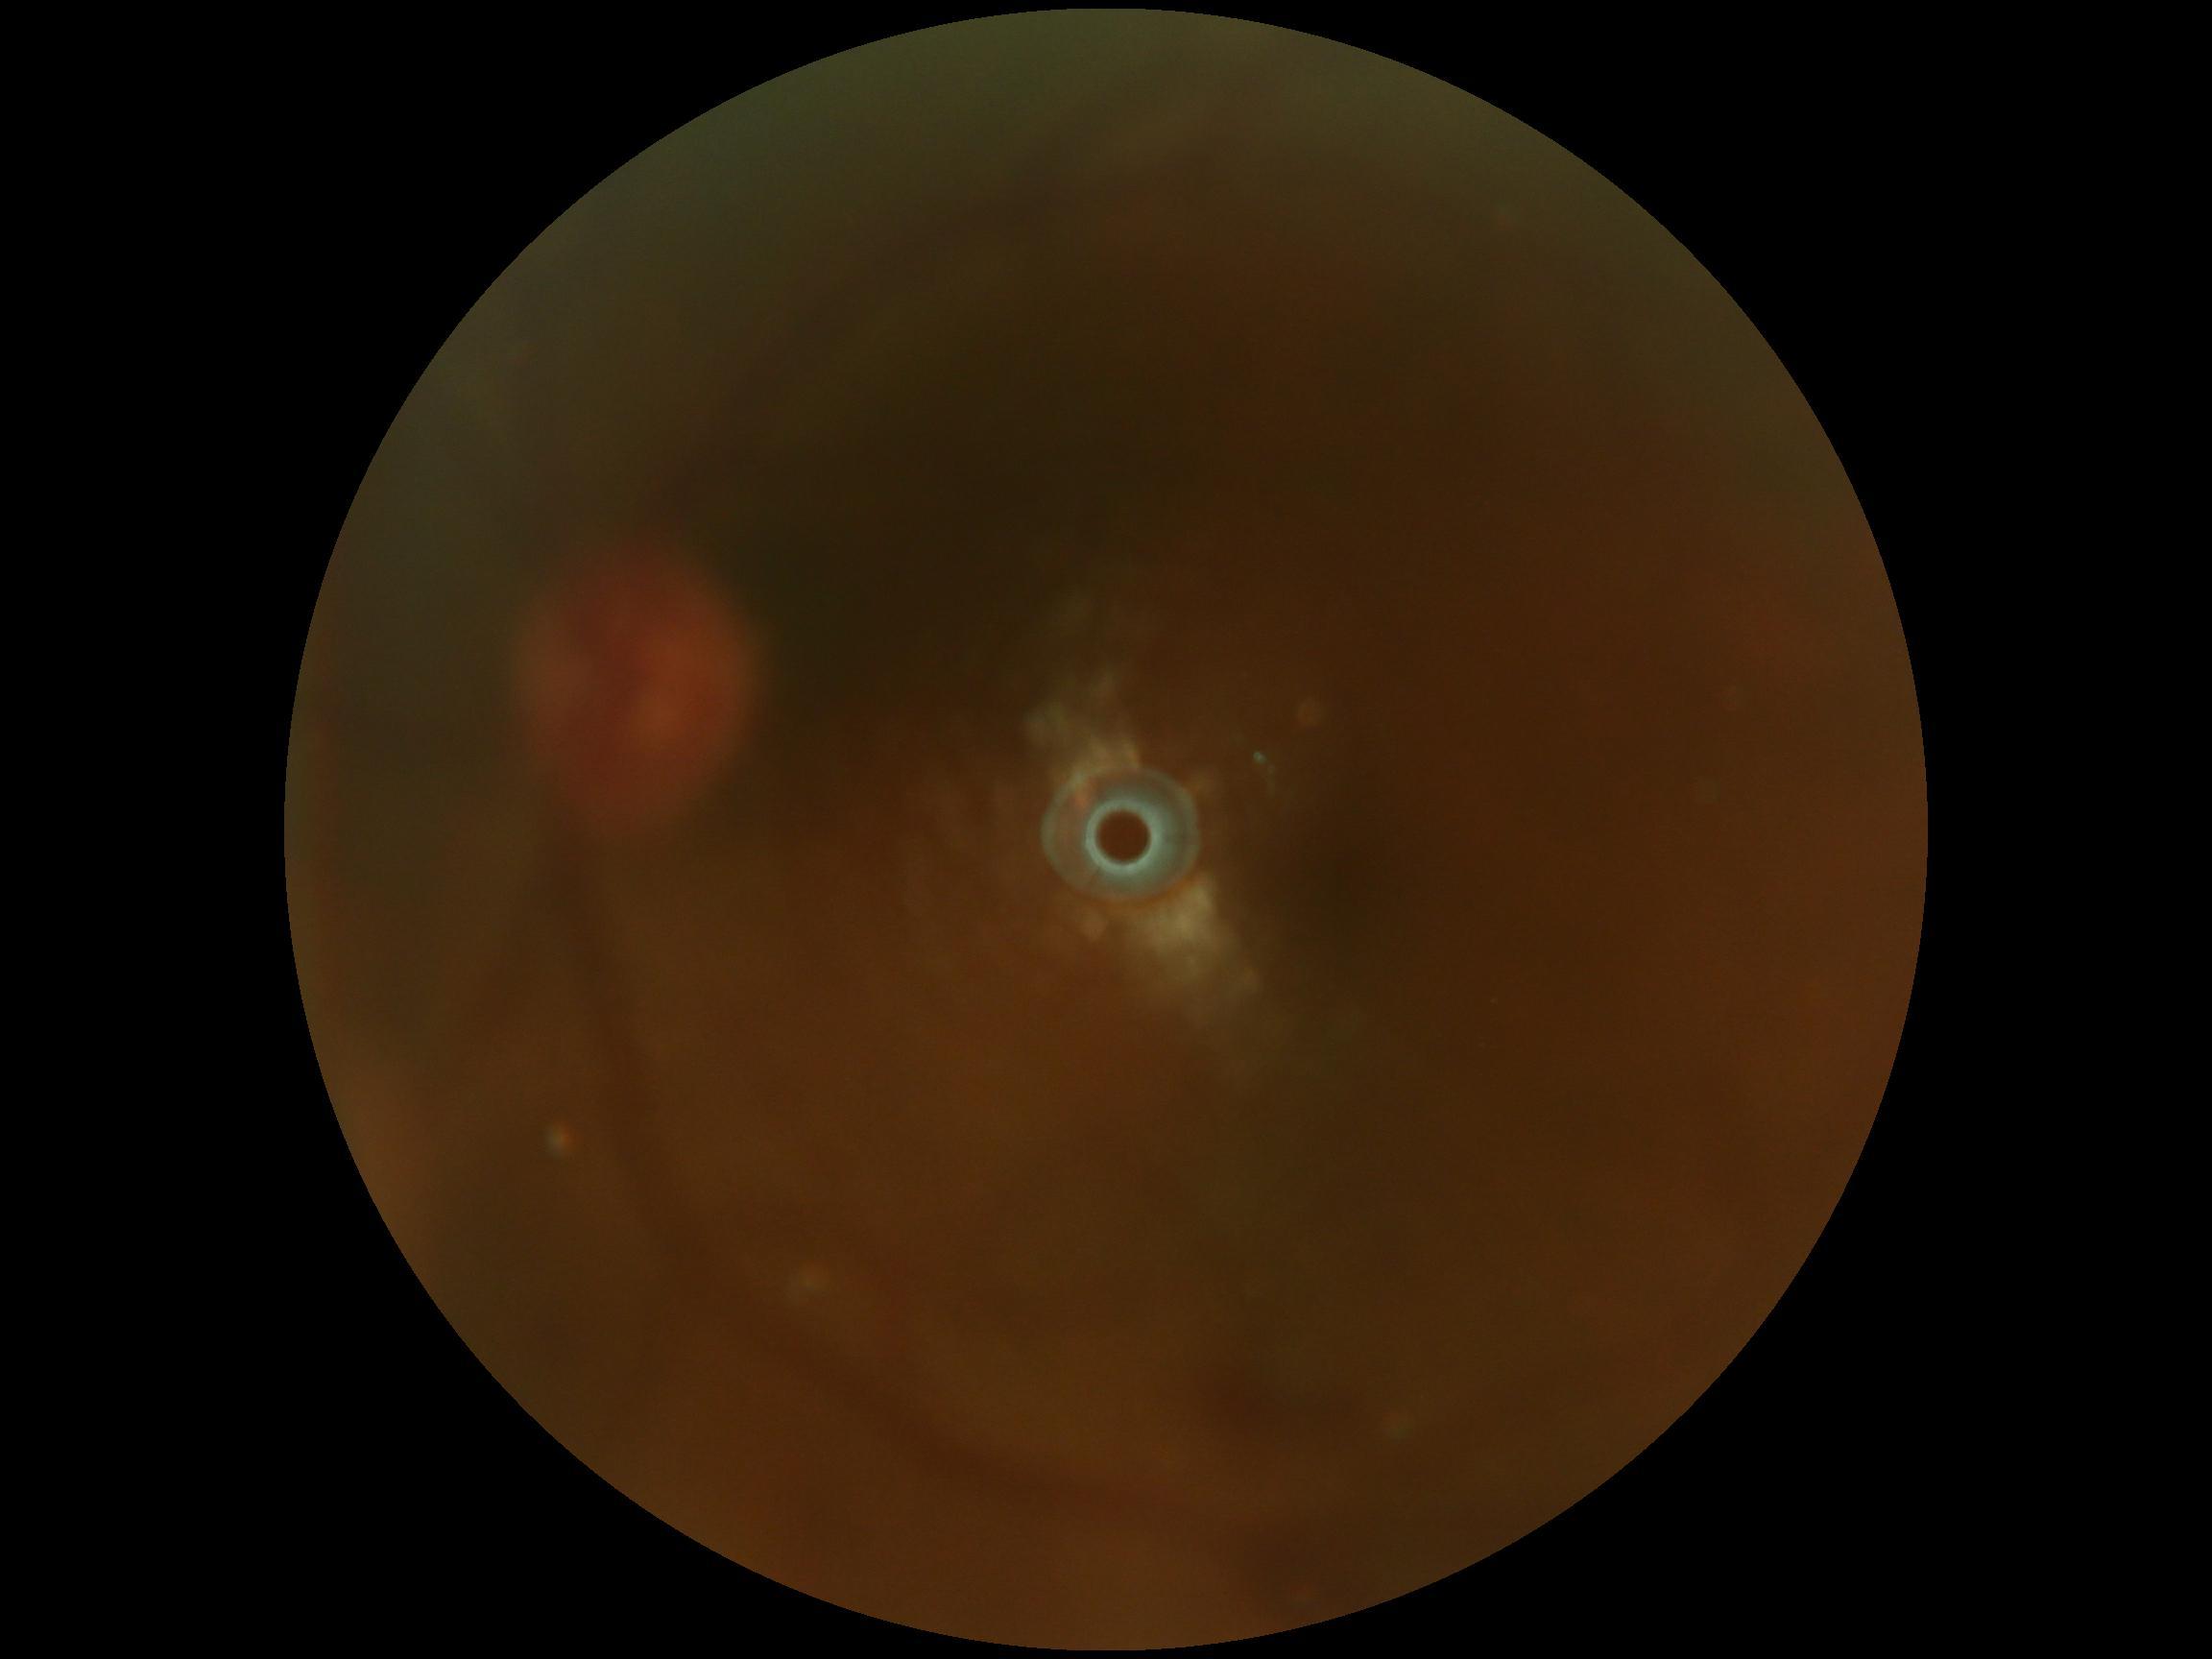
– diabetic retinopathy severity — ungradable due to poor image quality